Wide-field fundus photograph from neonatal ROP screening:
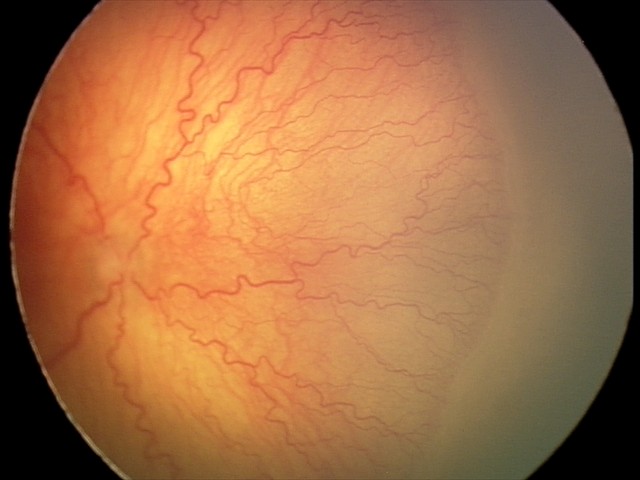 From an examination with diagnosis of aggressive retinopathy of prematurity (A-ROP). Plus disease was diagnosed.